Davis DR grading. No pharmacologic dilation
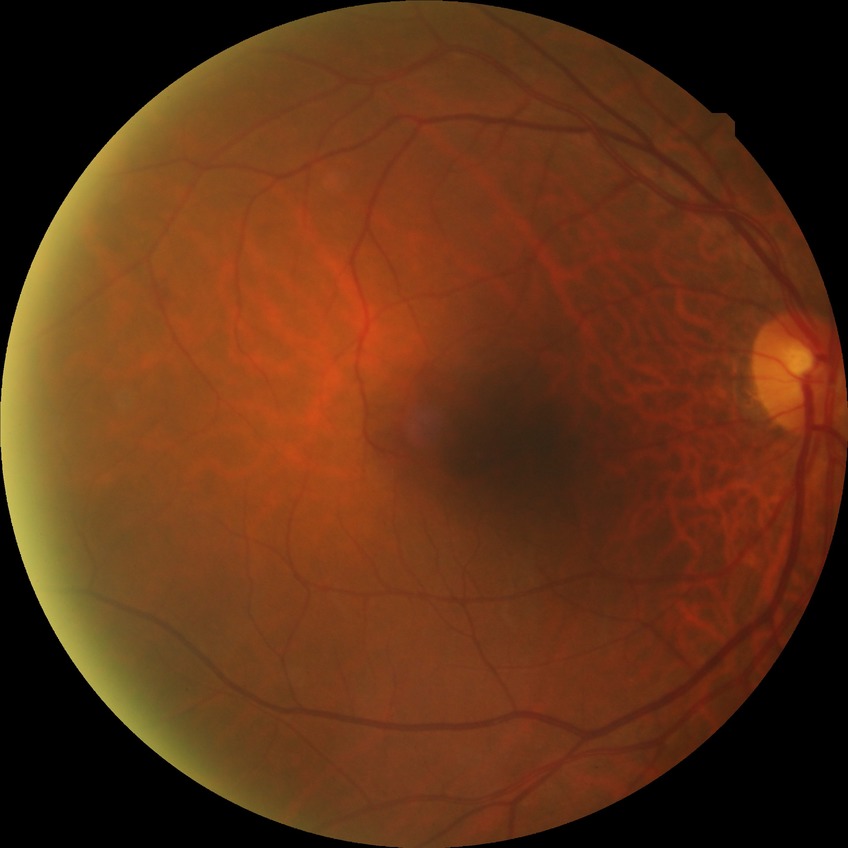

DR impression = no signs of DR; DR = NDR.